Color fundus photograph · 45-degree field of view
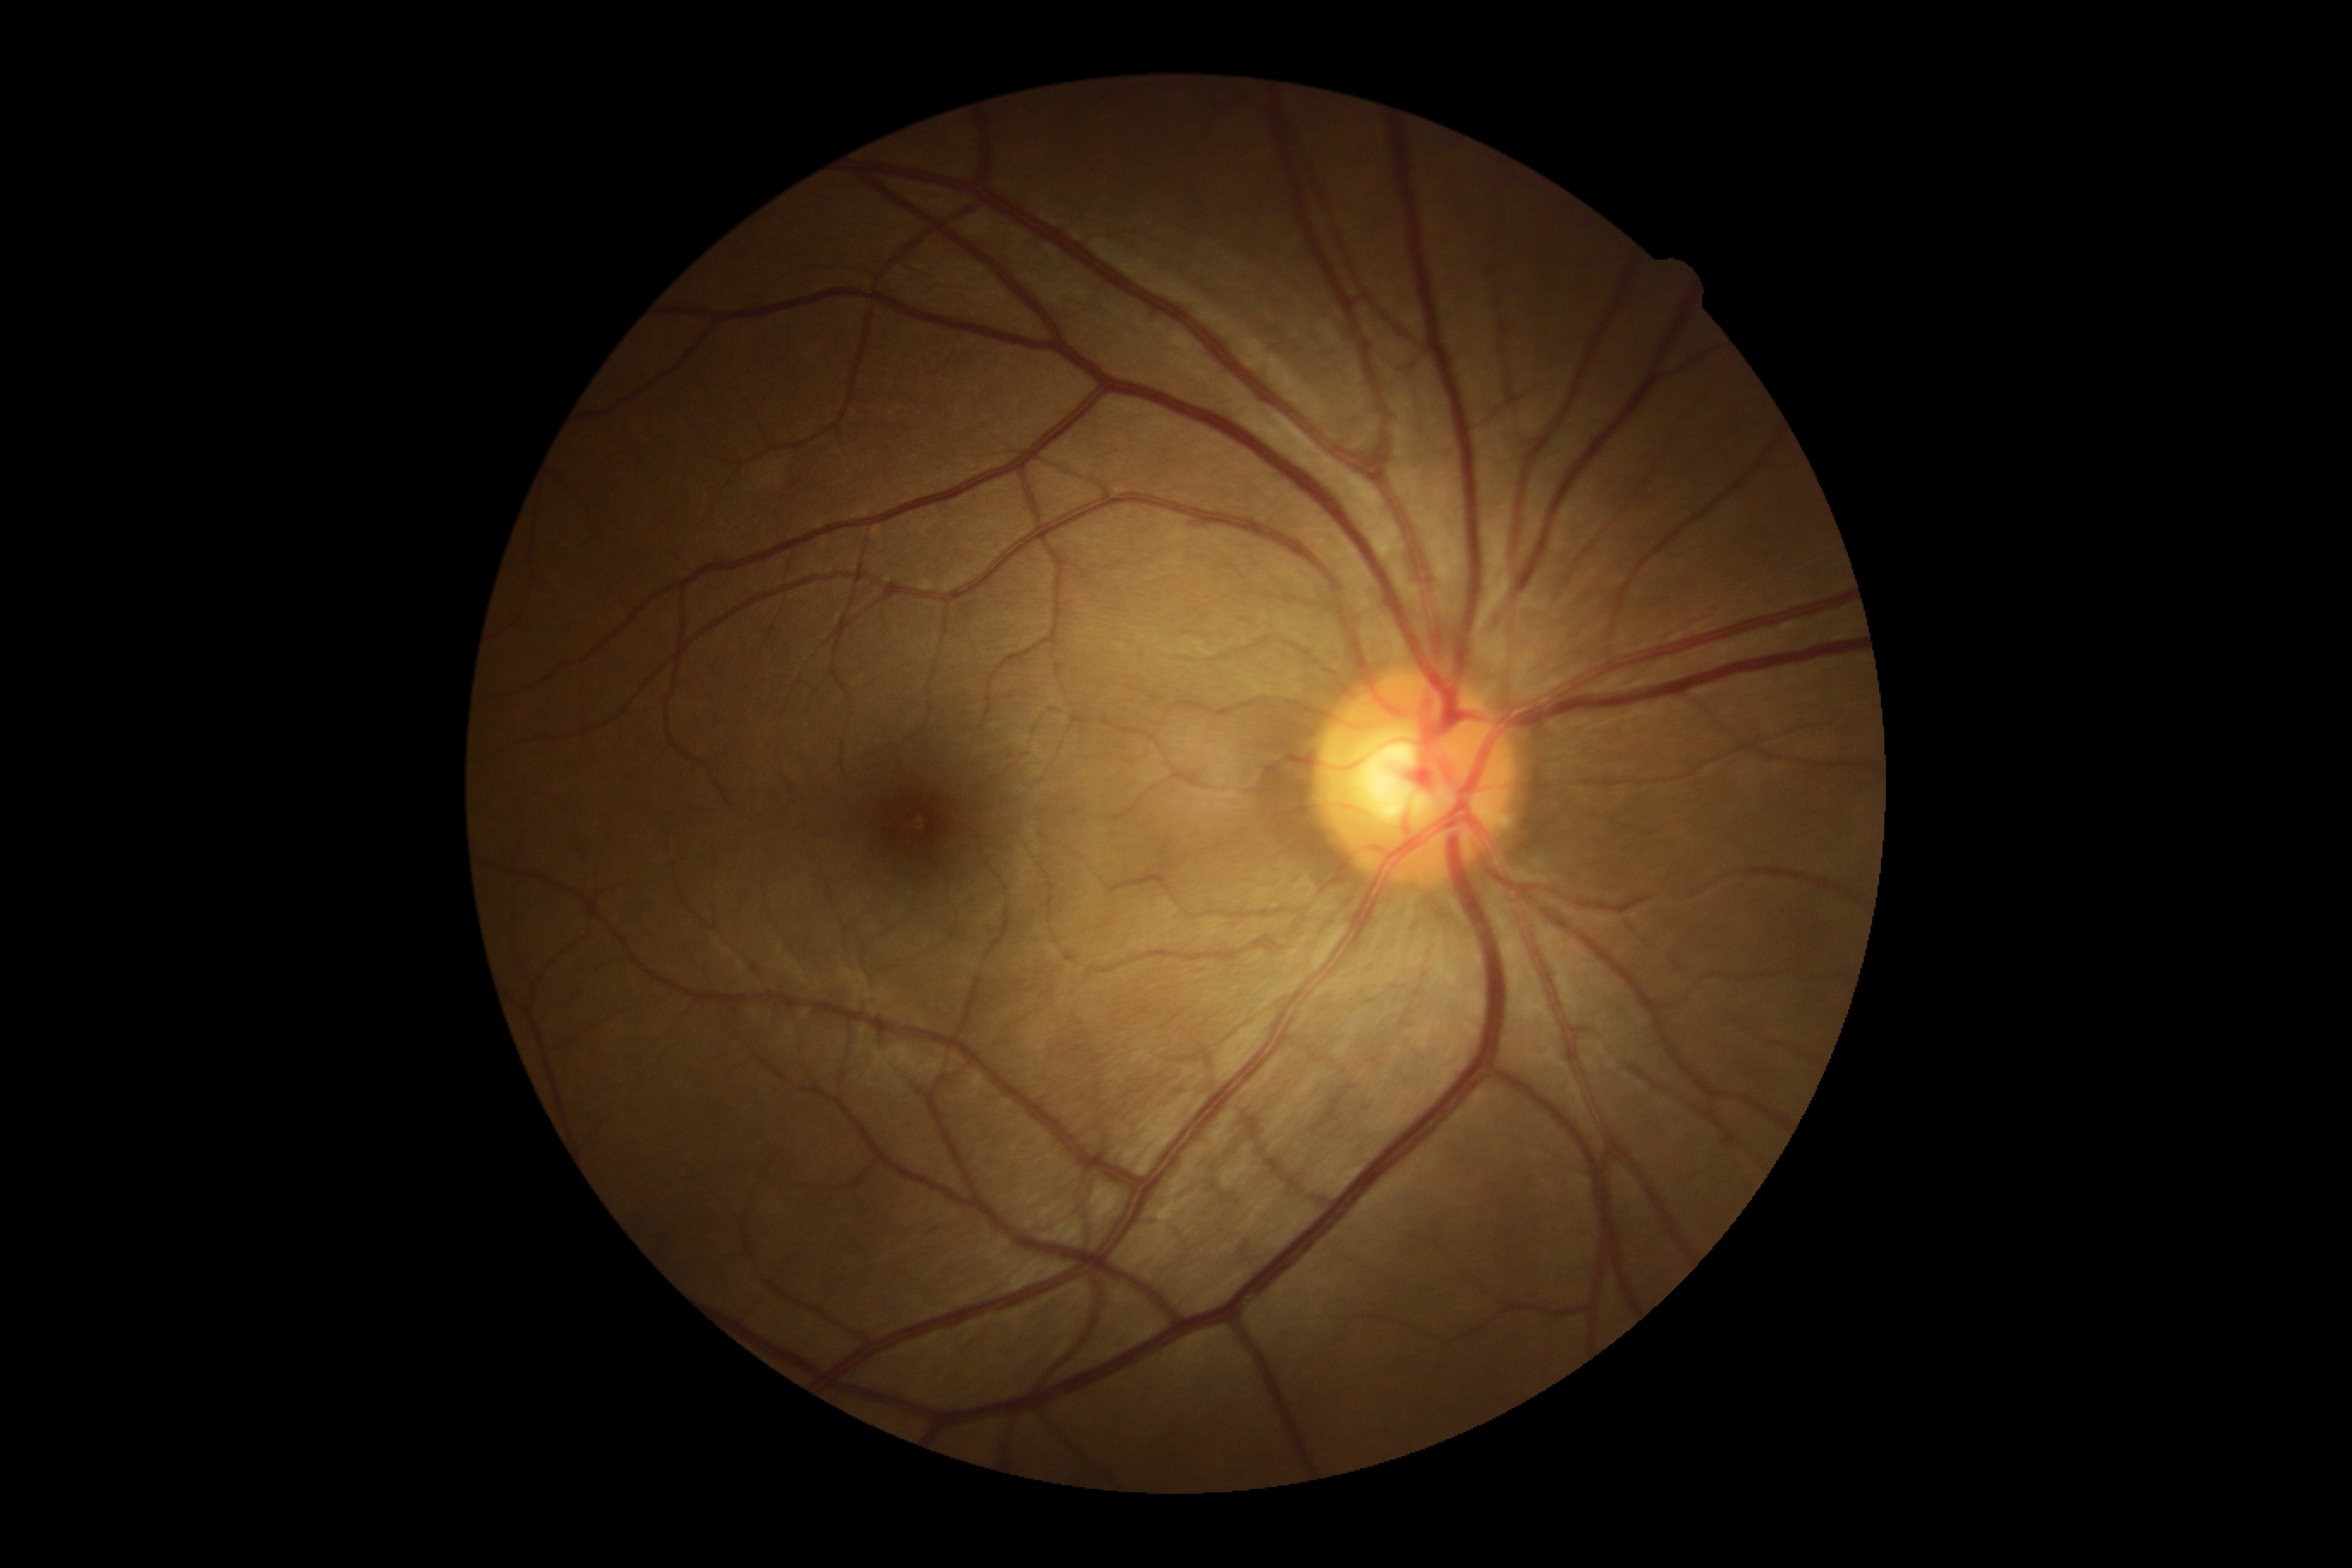
DR severity is no apparent diabetic retinopathy (grade 0) — no visible signs of diabetic retinopathy.